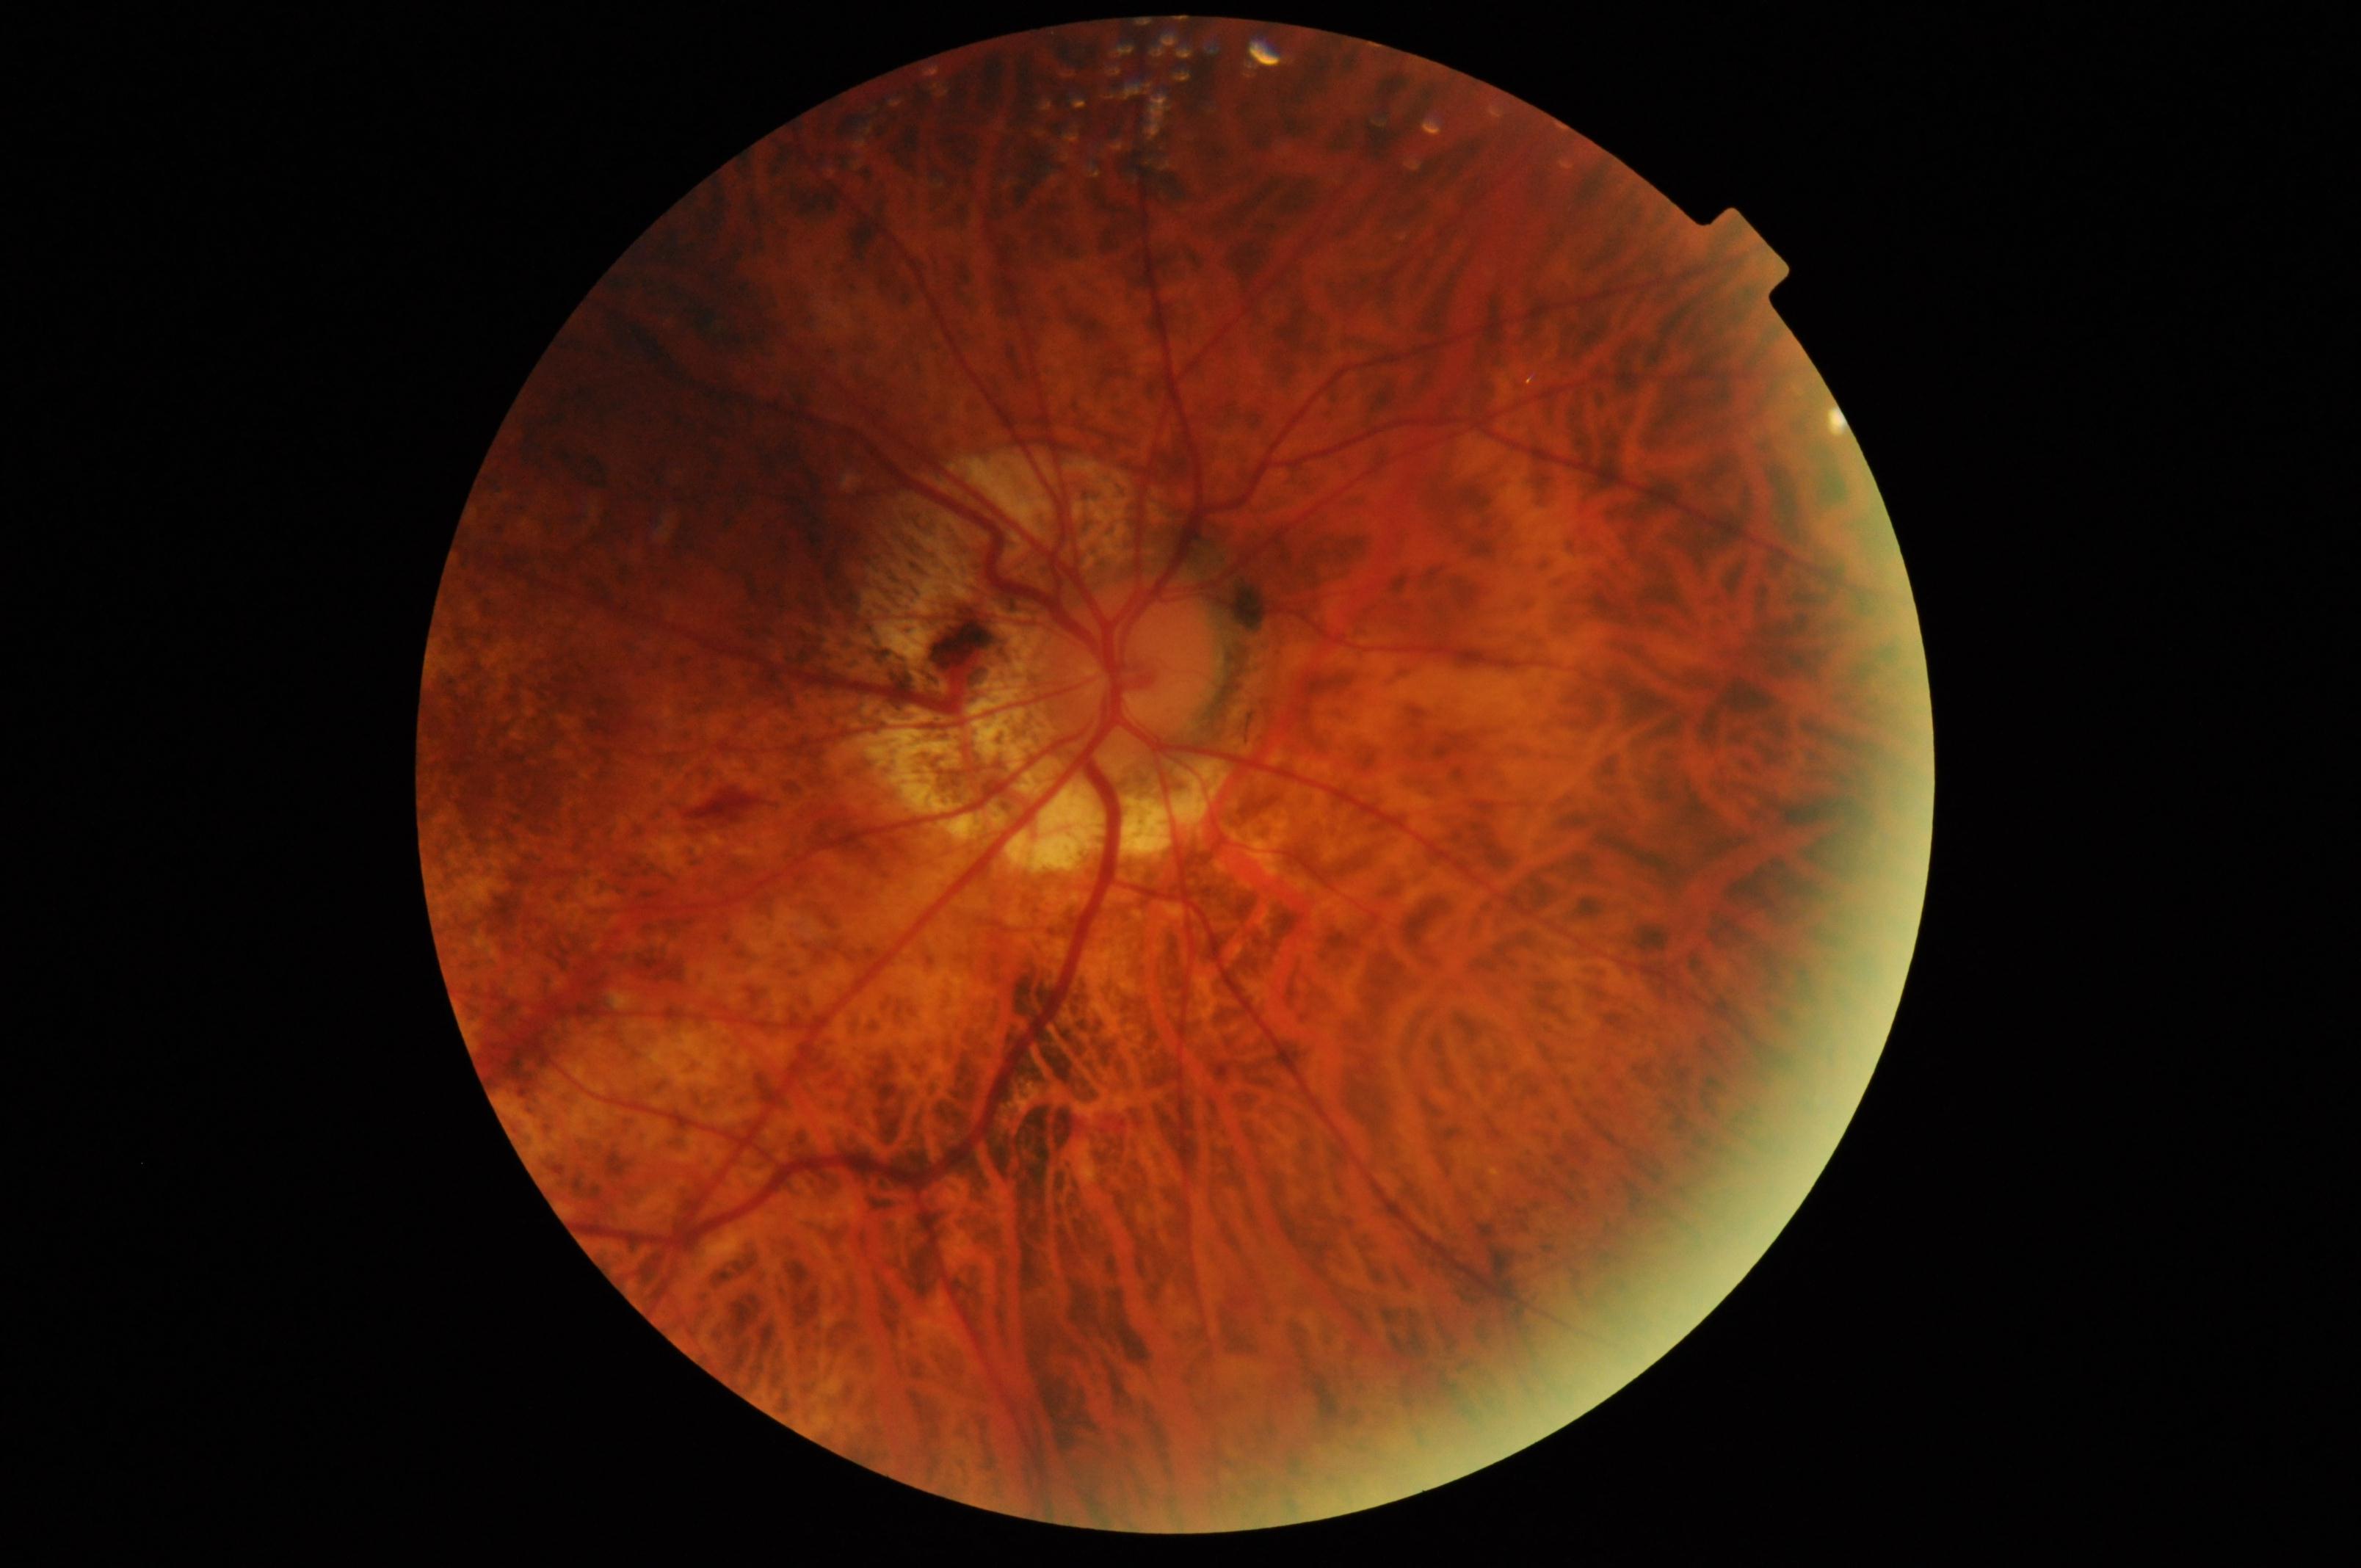 Primary finding: pathological myopia. Typically showing tessellated fundus with focal chorioretinal atrophy, Fuchs spot, lacquer cracks, choroidal neovascularization, or subretinal hemorrhage.